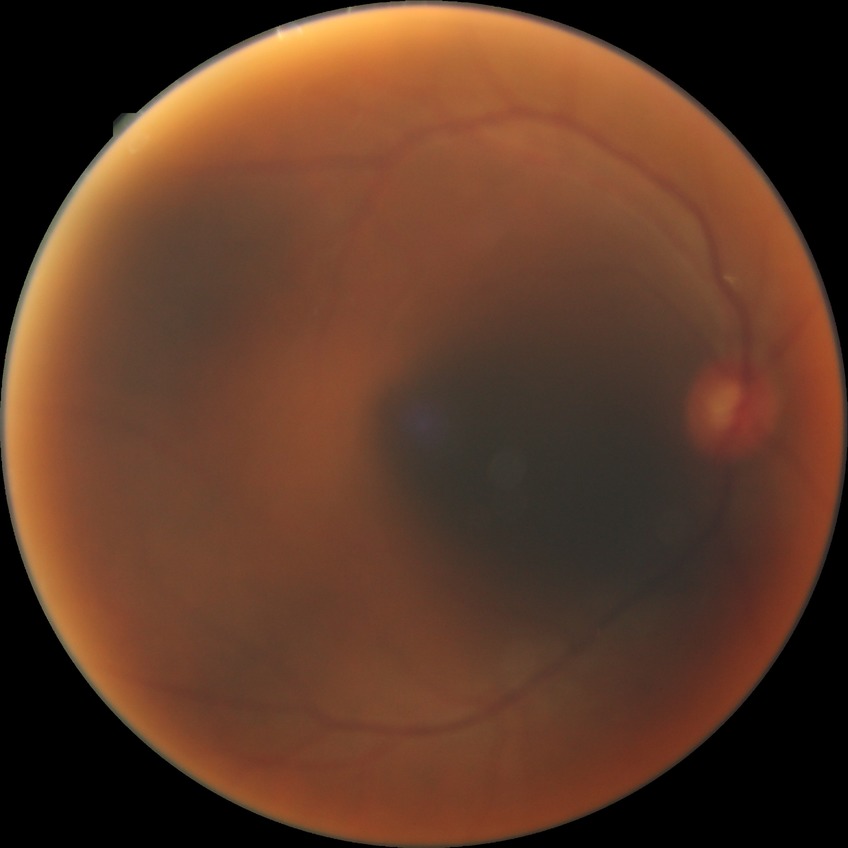
{
  "davis_grade": "no diabetic retinopathy (NDR)"
}